Modified Davis classification. No pharmacologic dilation. NIDEK AFC-230:
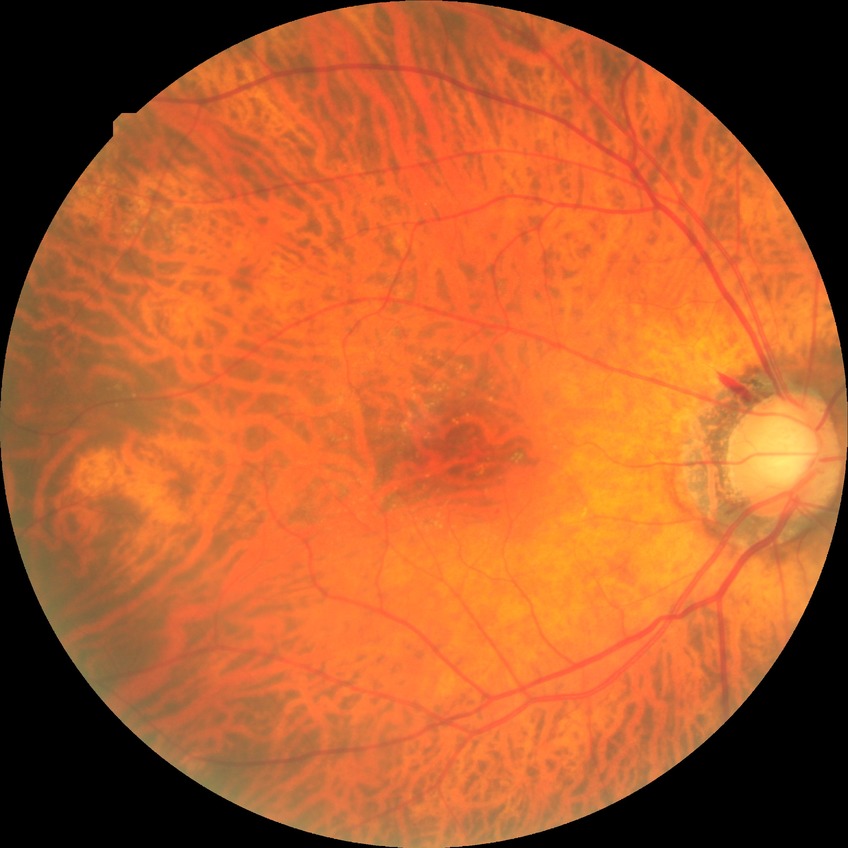   davis_grade: NDR